Non-mydriatic: 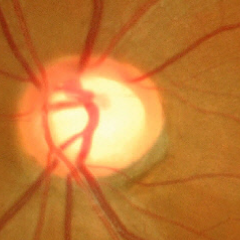

Glaucoma is present. Assessment: advanced-stage glaucoma.